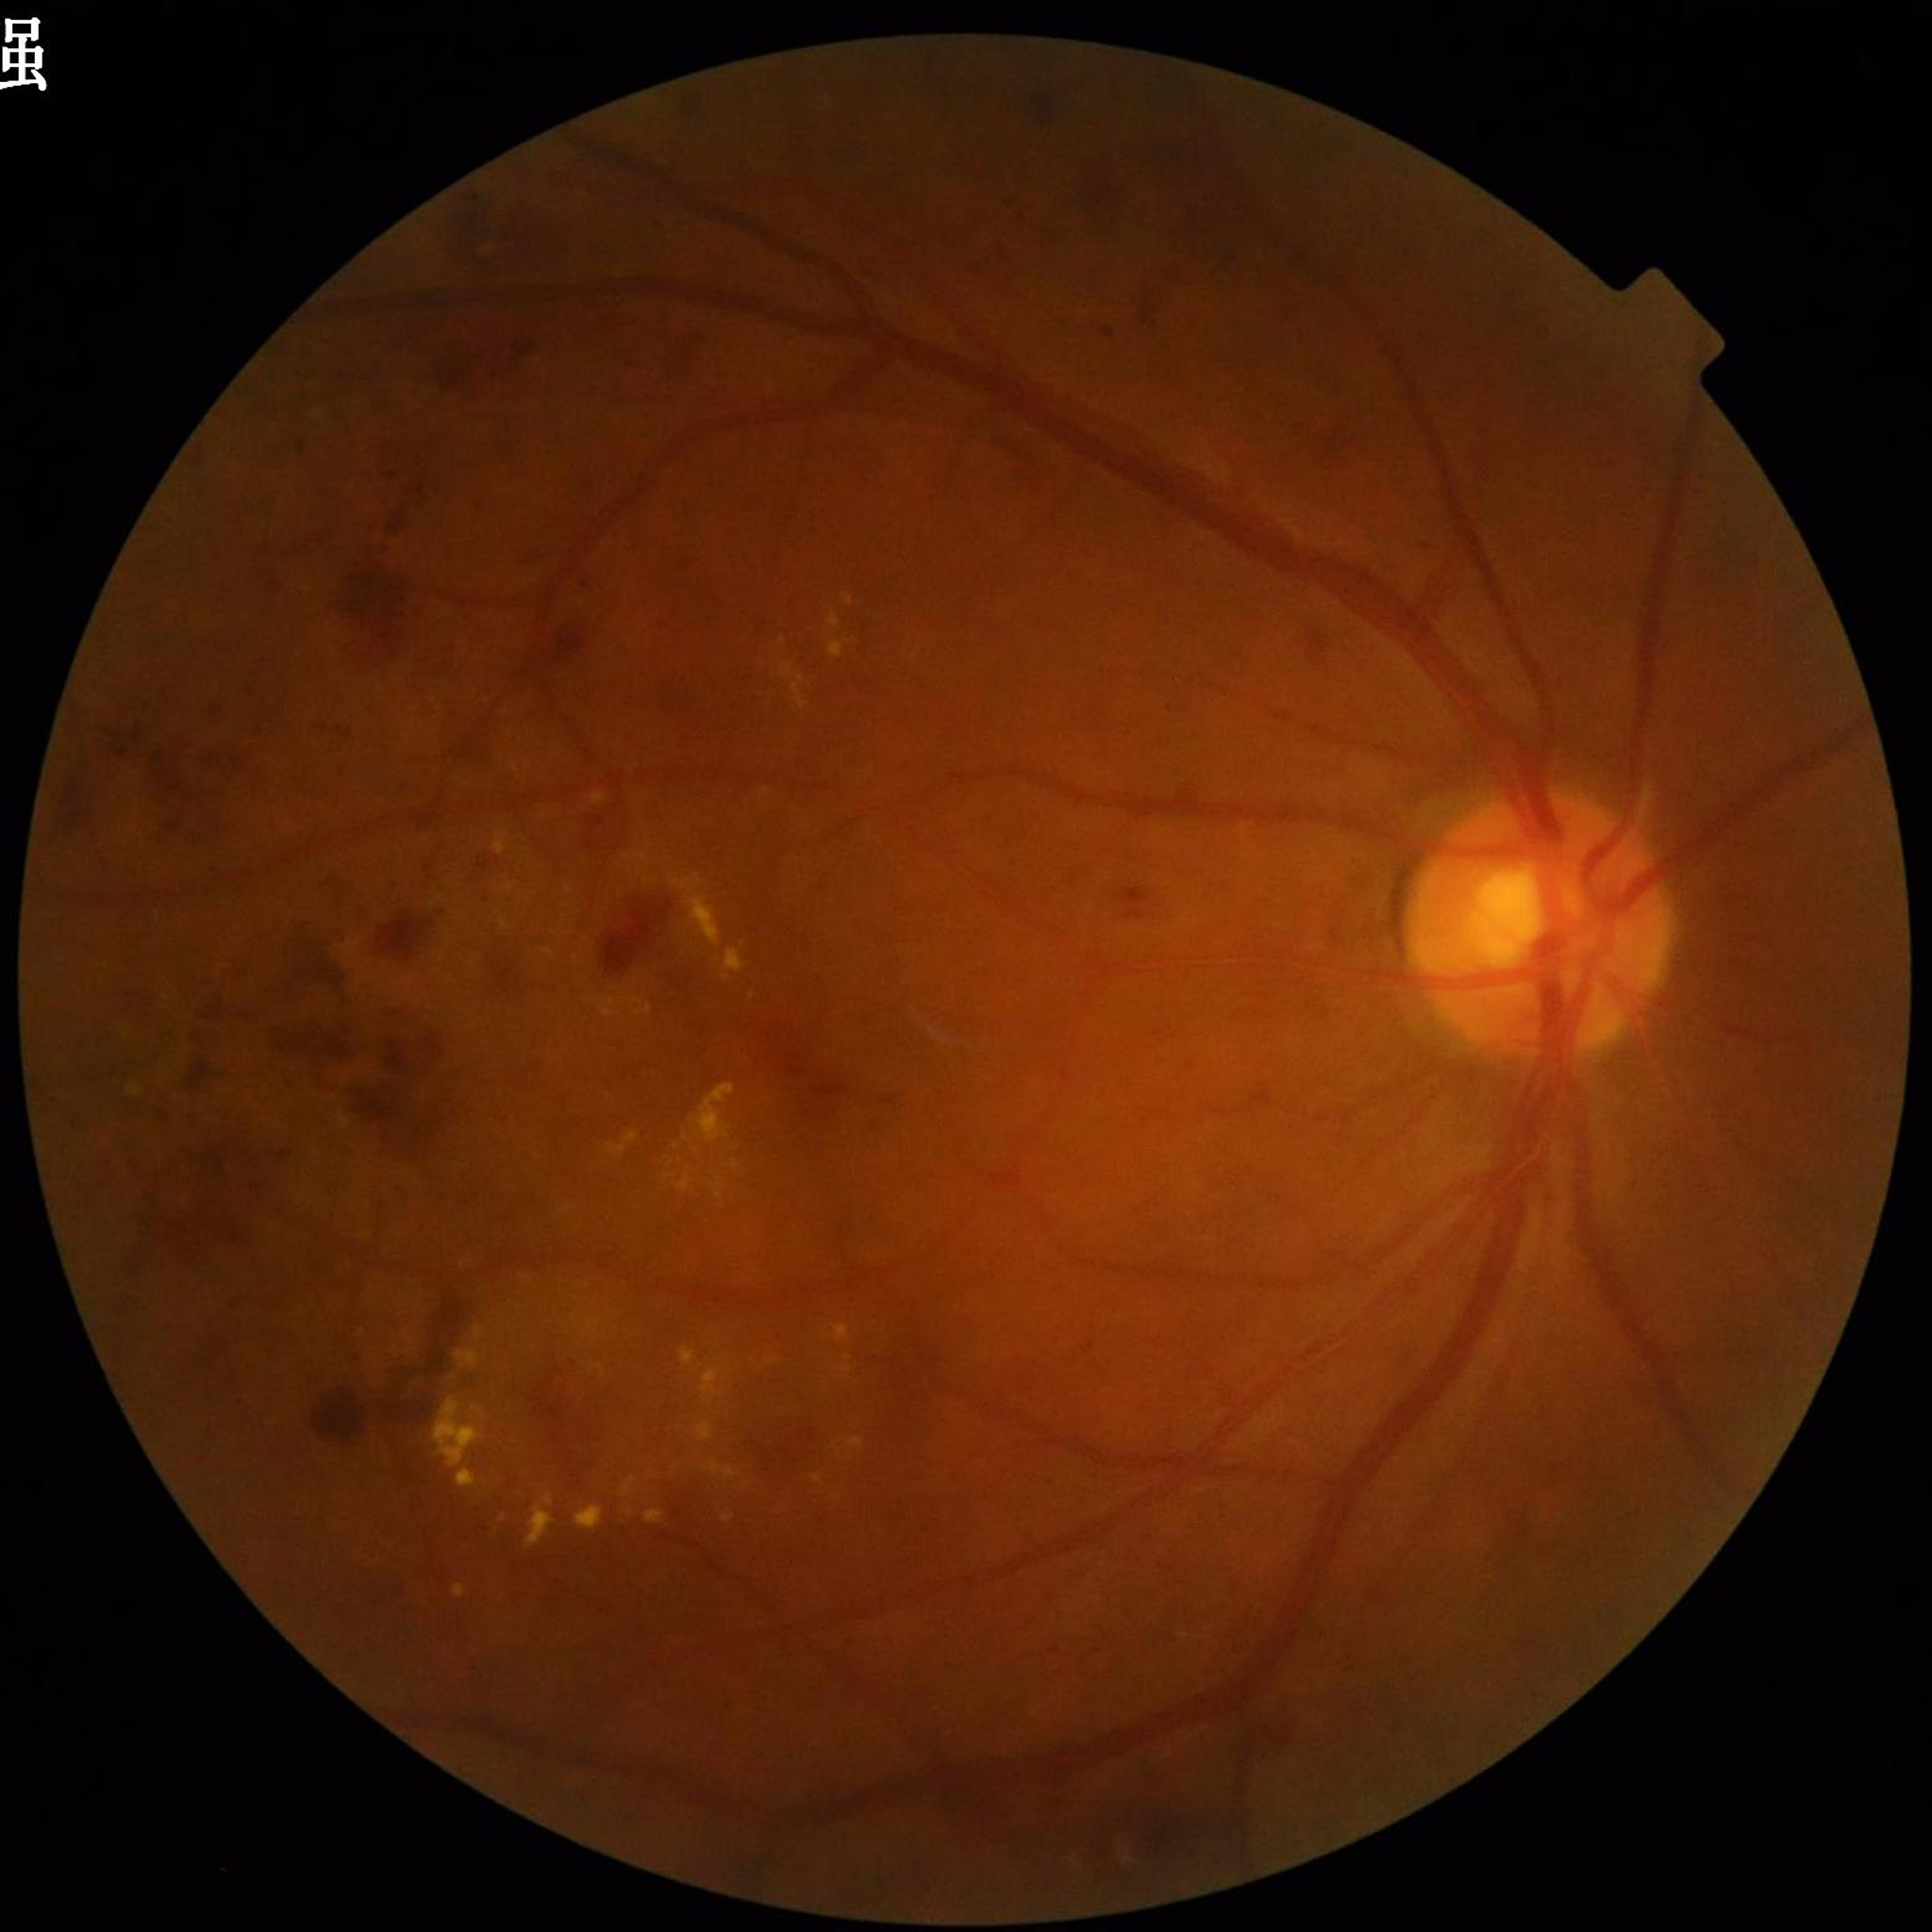

Image quality: no concerns identified. Fundus image of an eye with diabetic retinopathy.